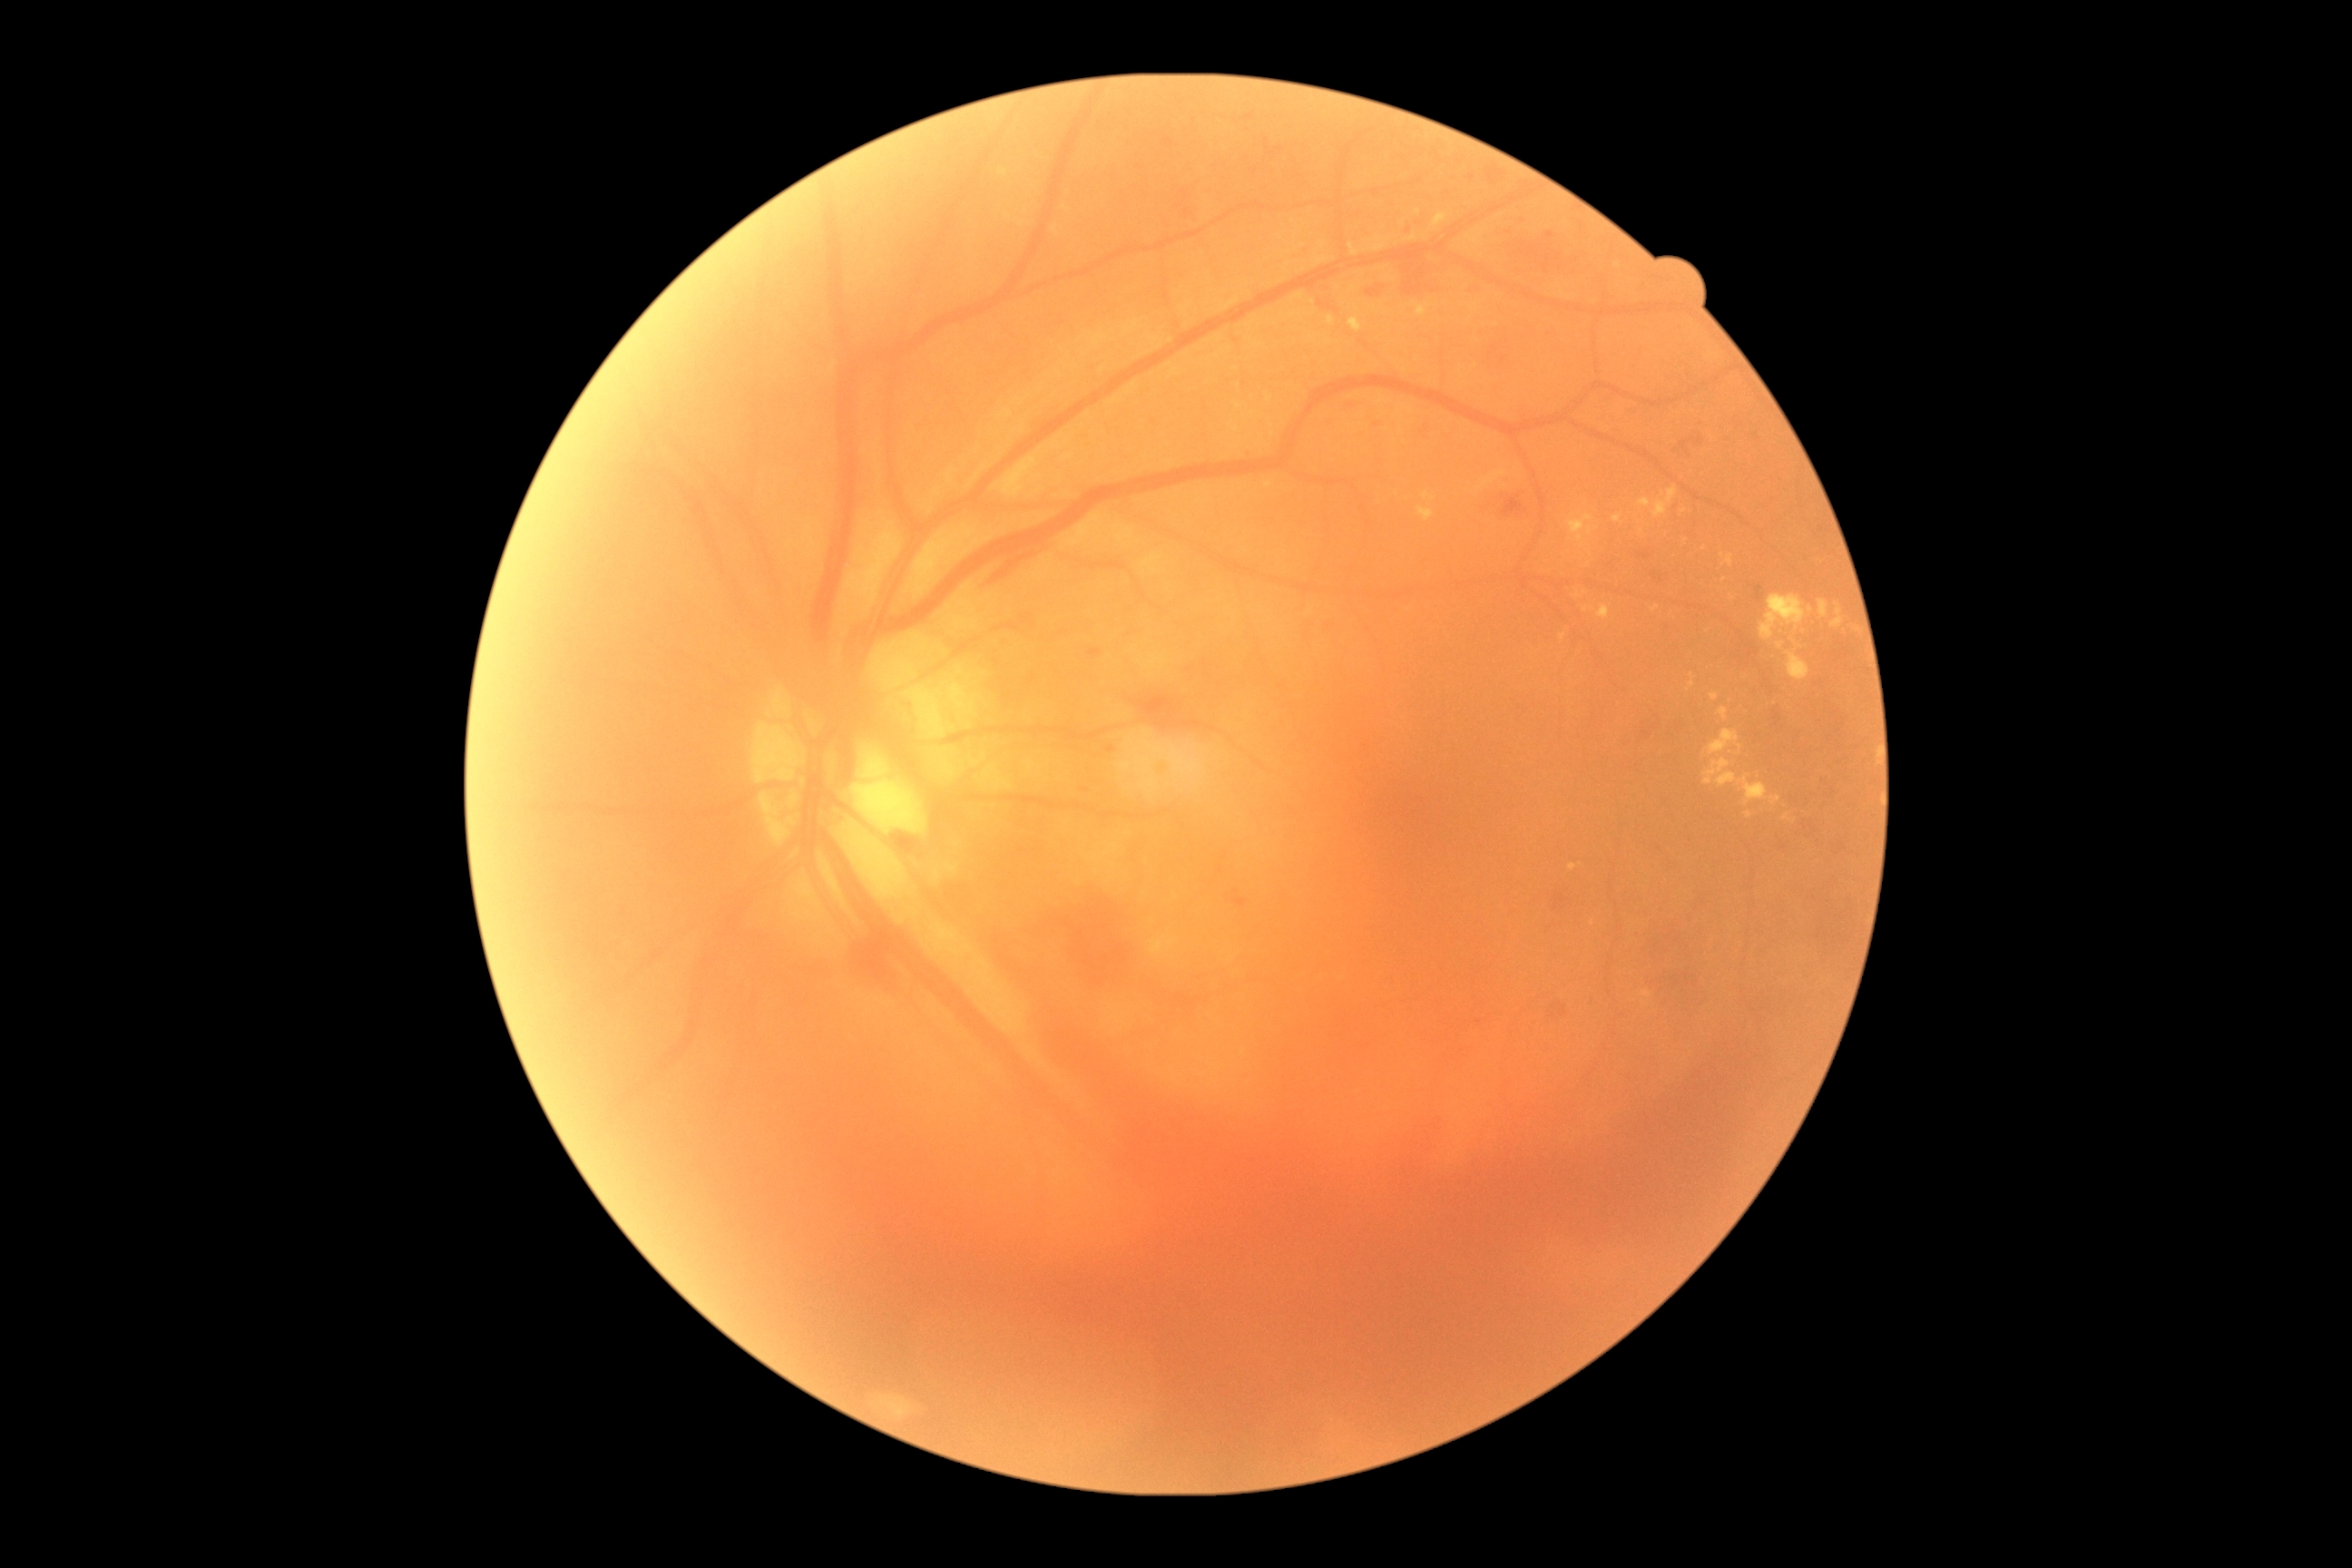

Diabetic retinopathy (DR) is 4/4. Hard exudates (EXs) include those at 1612 514 1622 524 | 1640 498 1651 507 | 1433 213 1447 228 | 1720 707 1729 720 | 1569 514 1594 547 | 1783 816 1792 821 | 1416 306 1427 317 | 1574 594 1582 600 | 1830 603 1845 629 | 1703 760 1769 805 | 1710 694 1720 701 | 1652 605 1660 612. Small EXs approximately at 1781, 646 | 1684, 511 | 1313, 302 | 1725, 580 | 1592, 923. Hemorrhages (HEs) include those at 856 917 903 981 | 1161 994 1210 1023 | 1396 257 1446 295 | 1692 438 1703 446 | 830 930 1774 1480 | 1485 168 1504 184 | 1554 896 1569 910 | 1642 720 1660 730 | 1504 237 1591 282 | 1680 440 1690 453. Small HEs approximately at 1156, 987. Microaneurysms (MAs) include those at 1090 649 1101 658 | 1233 897 1246 906 | 1631 407 1636 415 | 1406 226 1415 233. Small MAs approximately at 1550, 236 | 1111, 750 | 1525, 218 | 1472, 178 | 1085, 790. No soft exudates (SEs) identified.